FOV: 45 degrees:
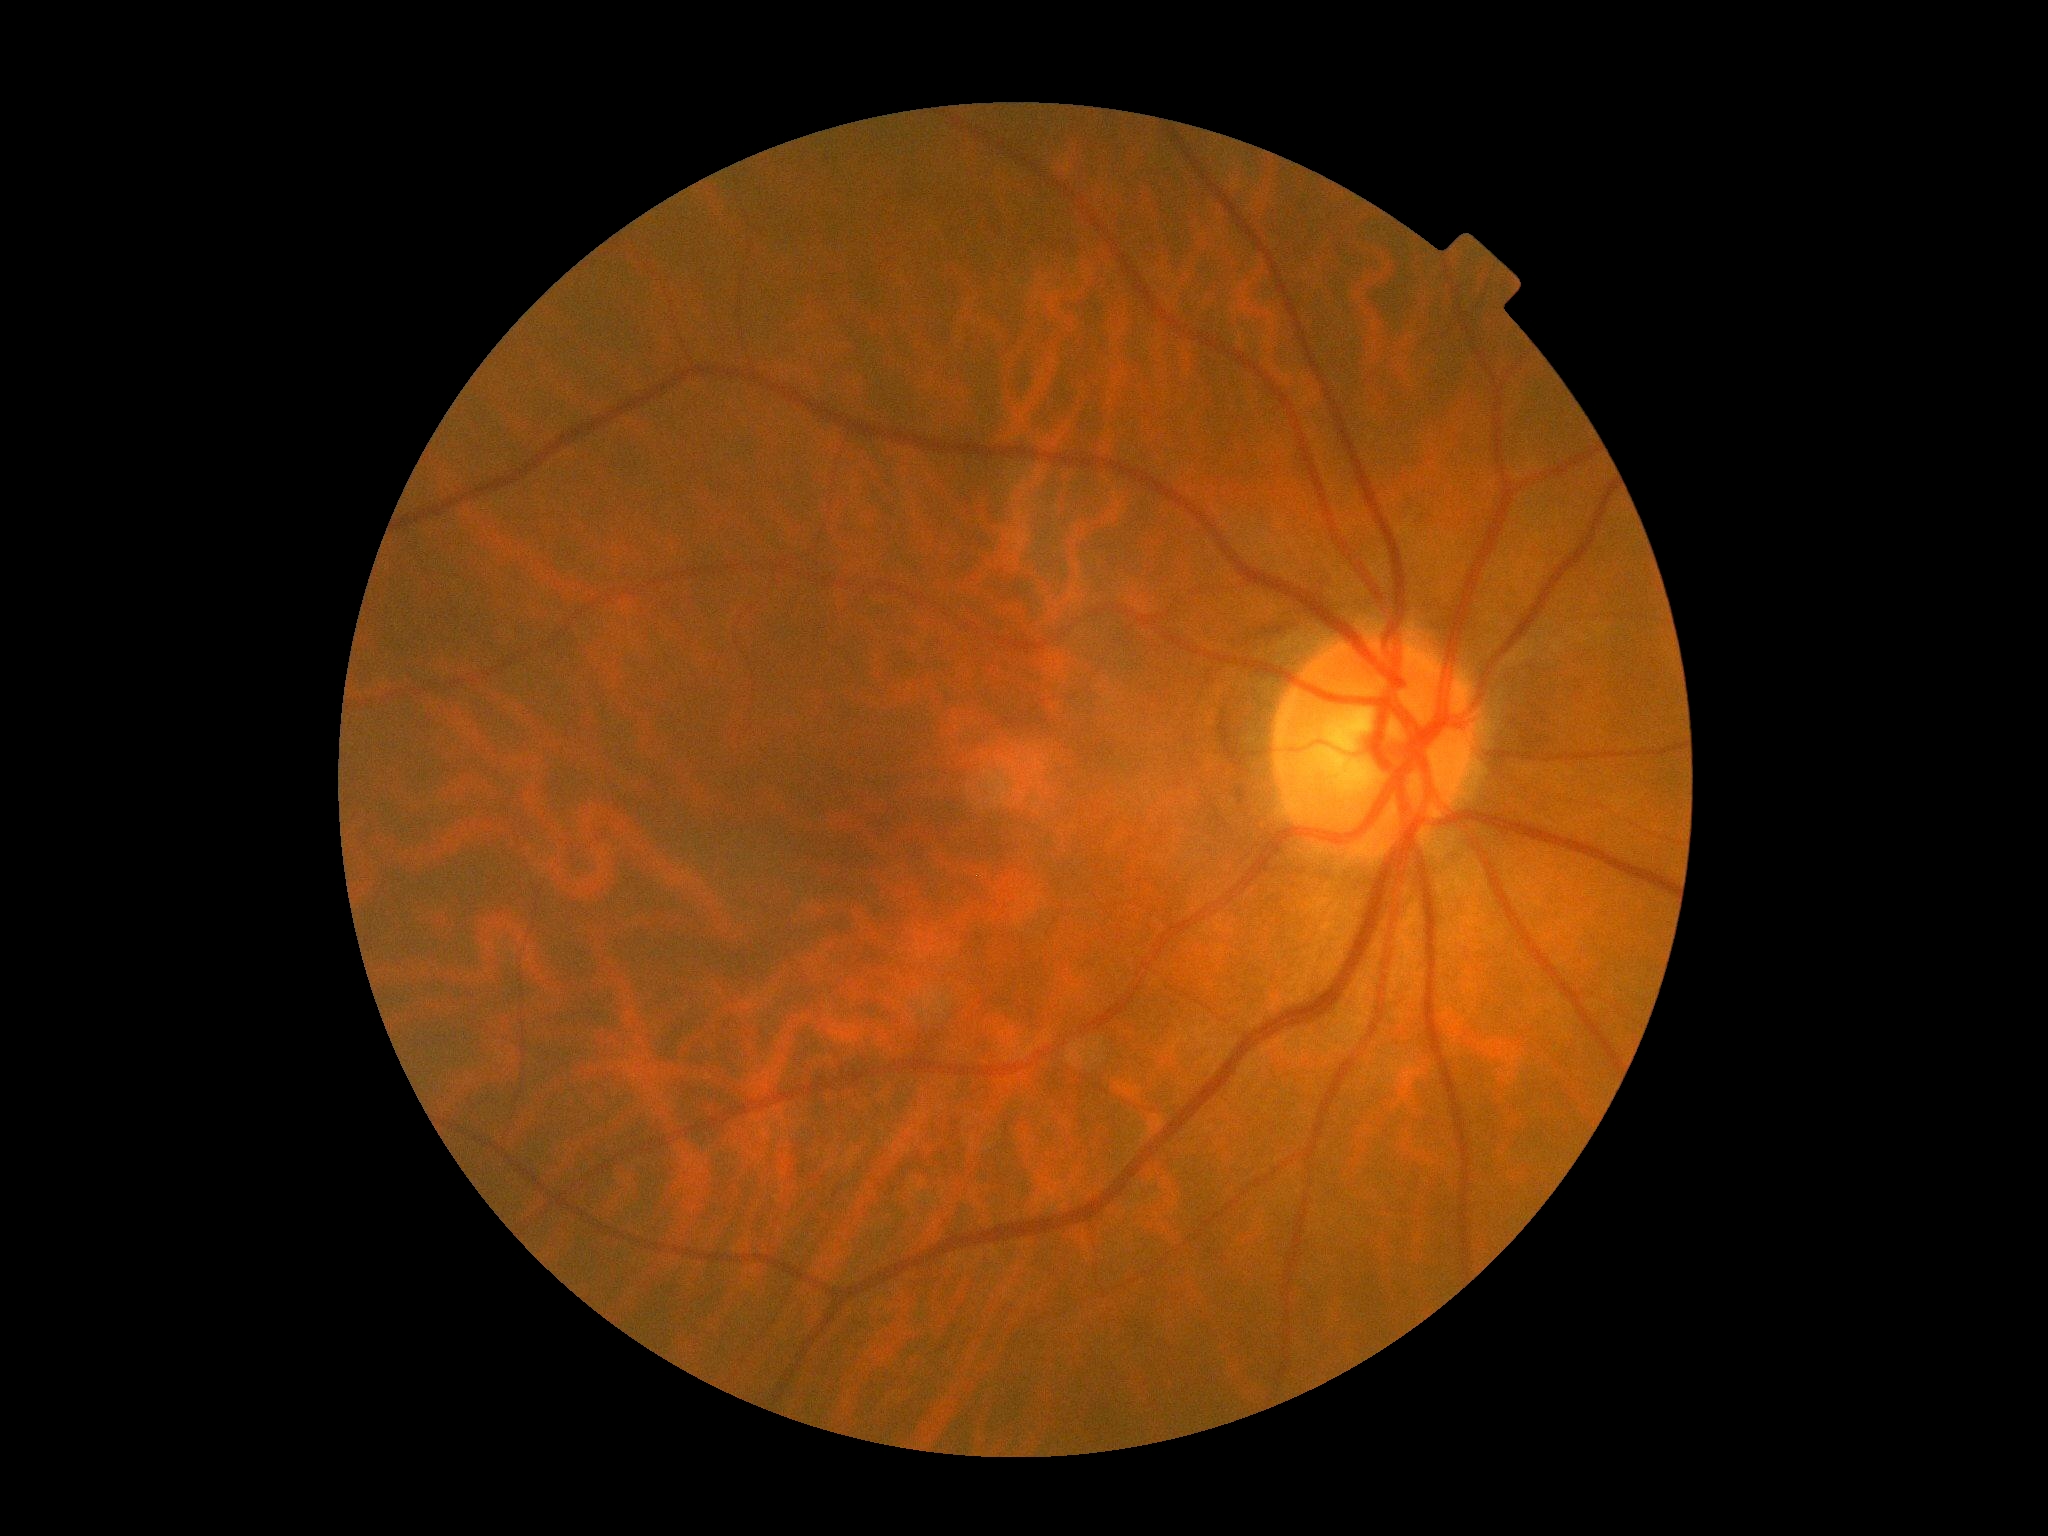

DR: no apparent retinopathy (grade 0).